Modified Davis classification · posterior pole photograph: 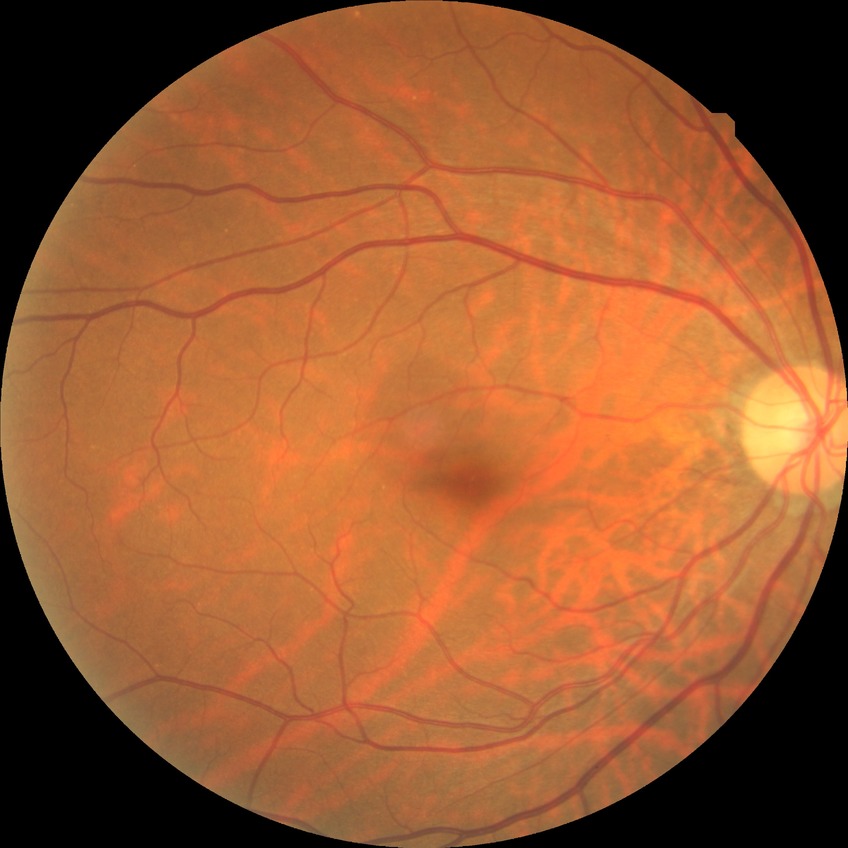 Davis grading: no diabetic retinopathy.